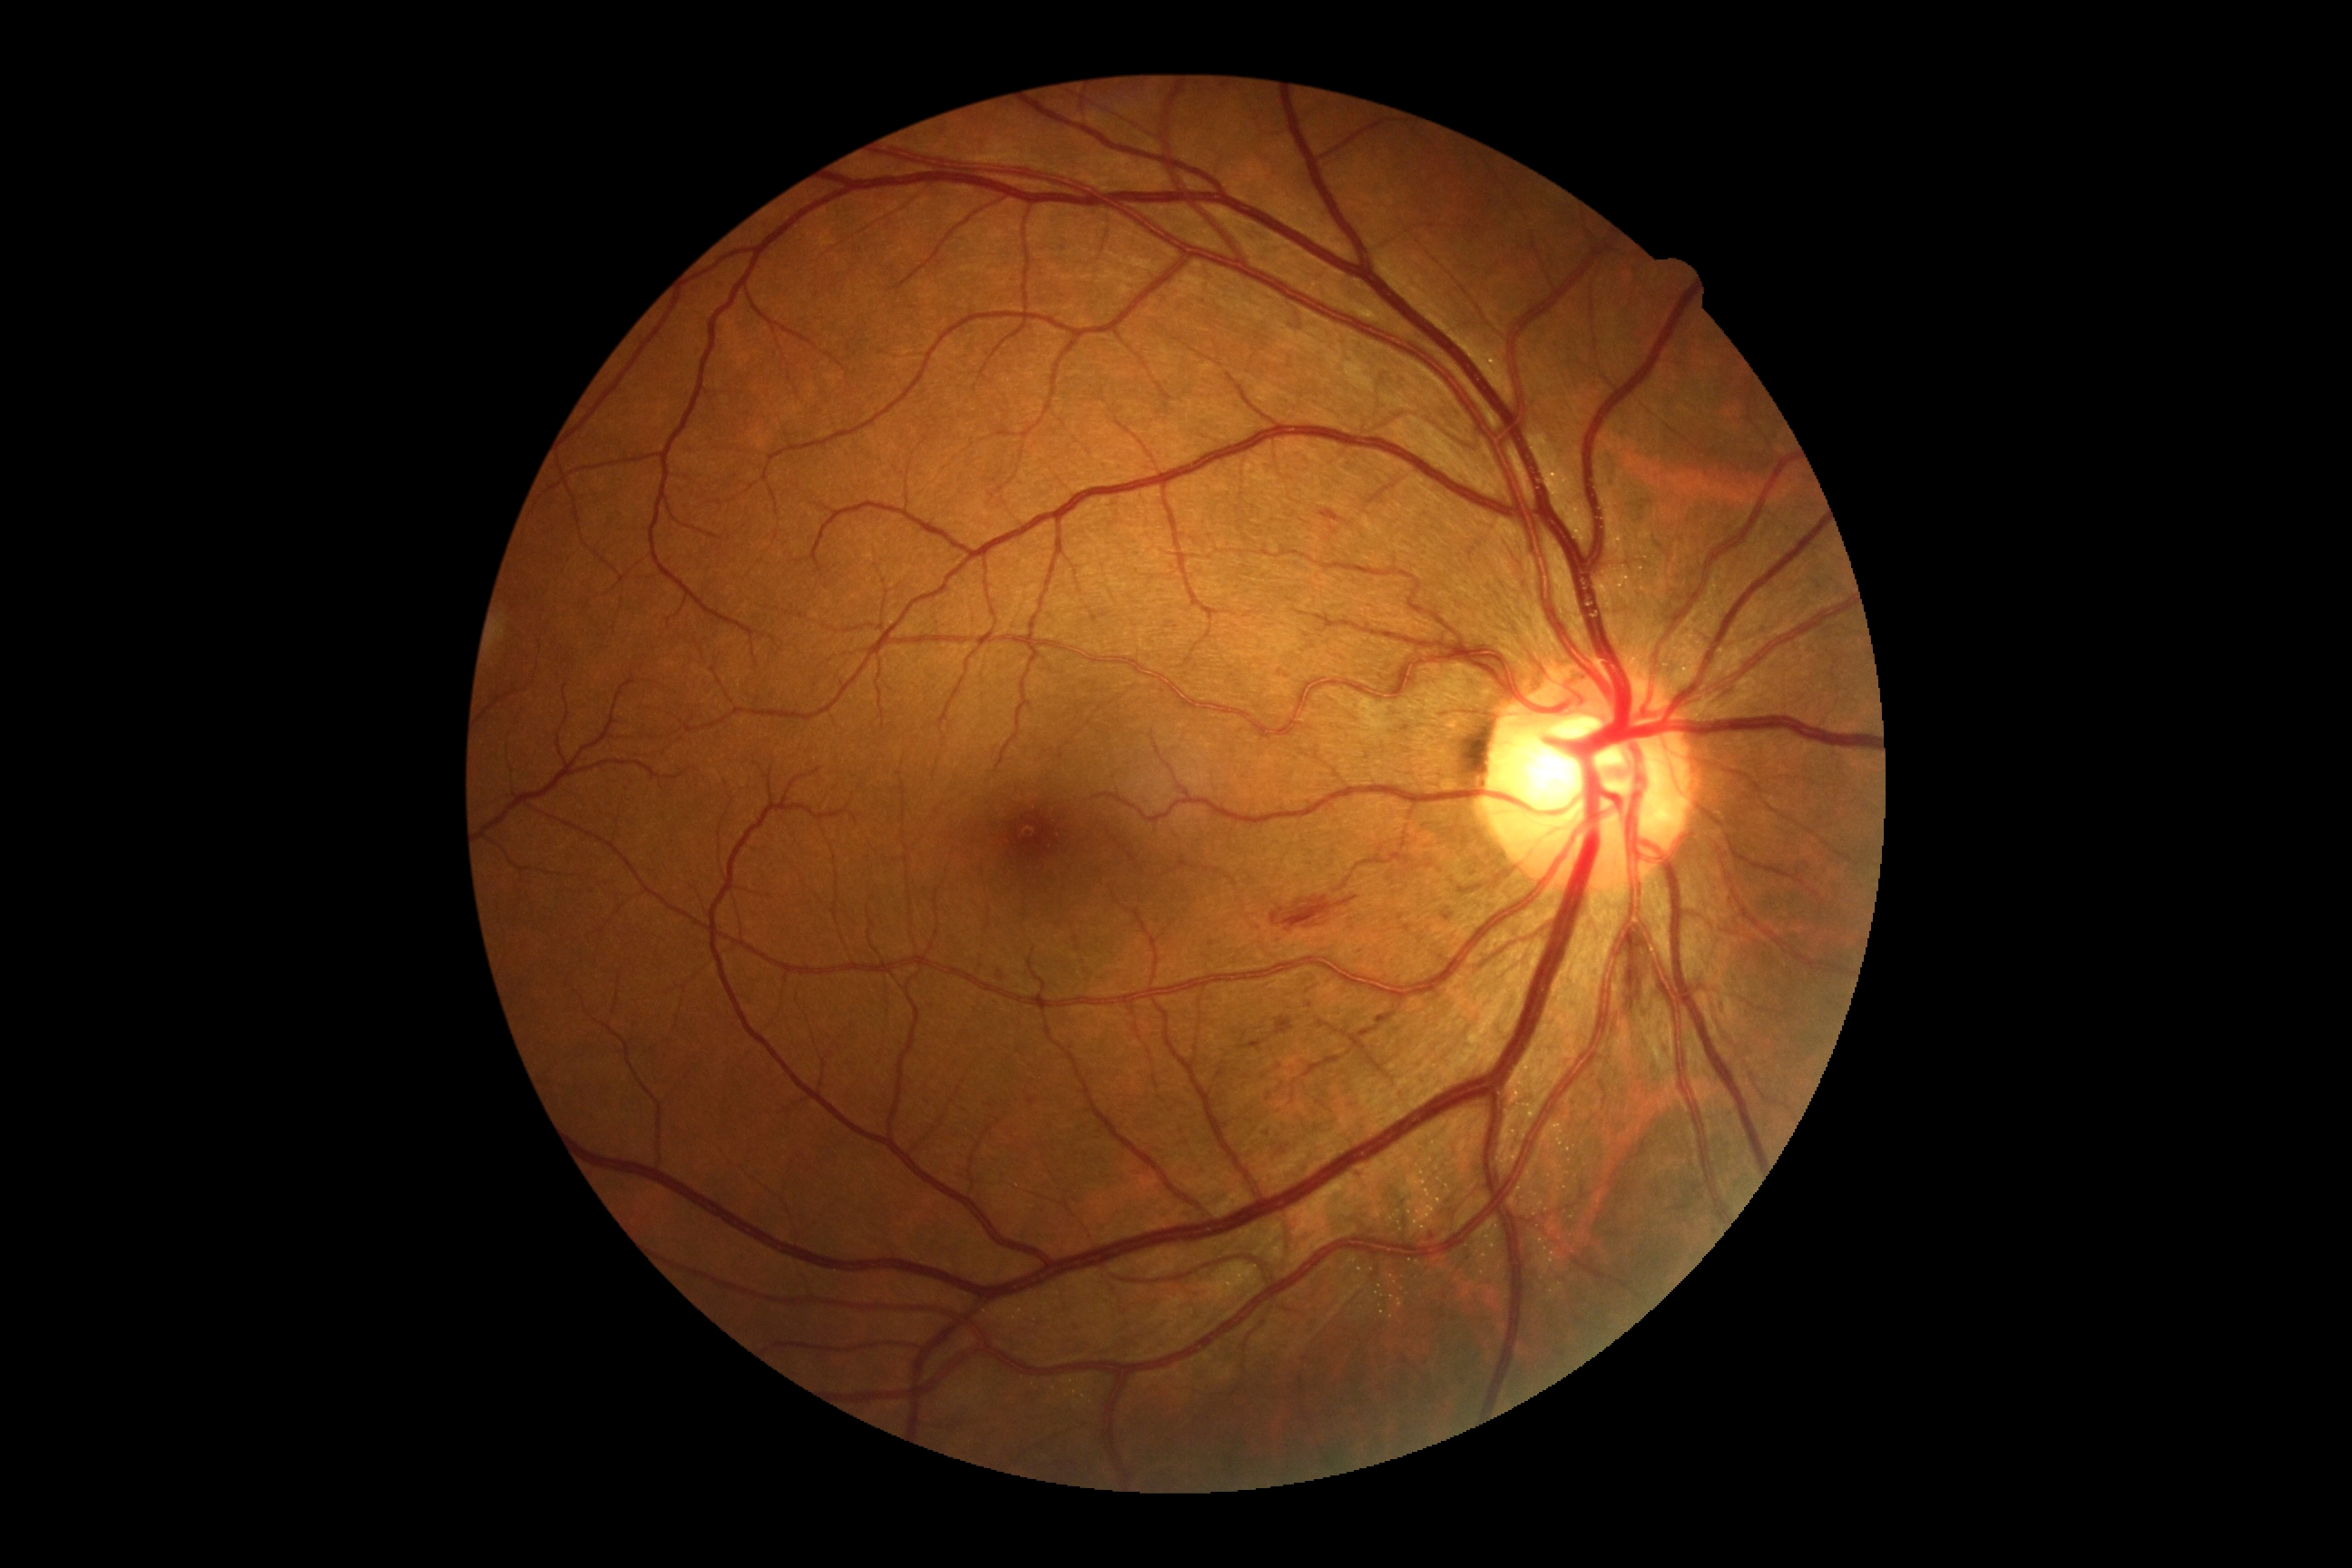 Diabetic retinopathy (DR): grade 2 (moderate NPDR).